Fundus photo, image size 1932x1910, FOV: 45 degrees: 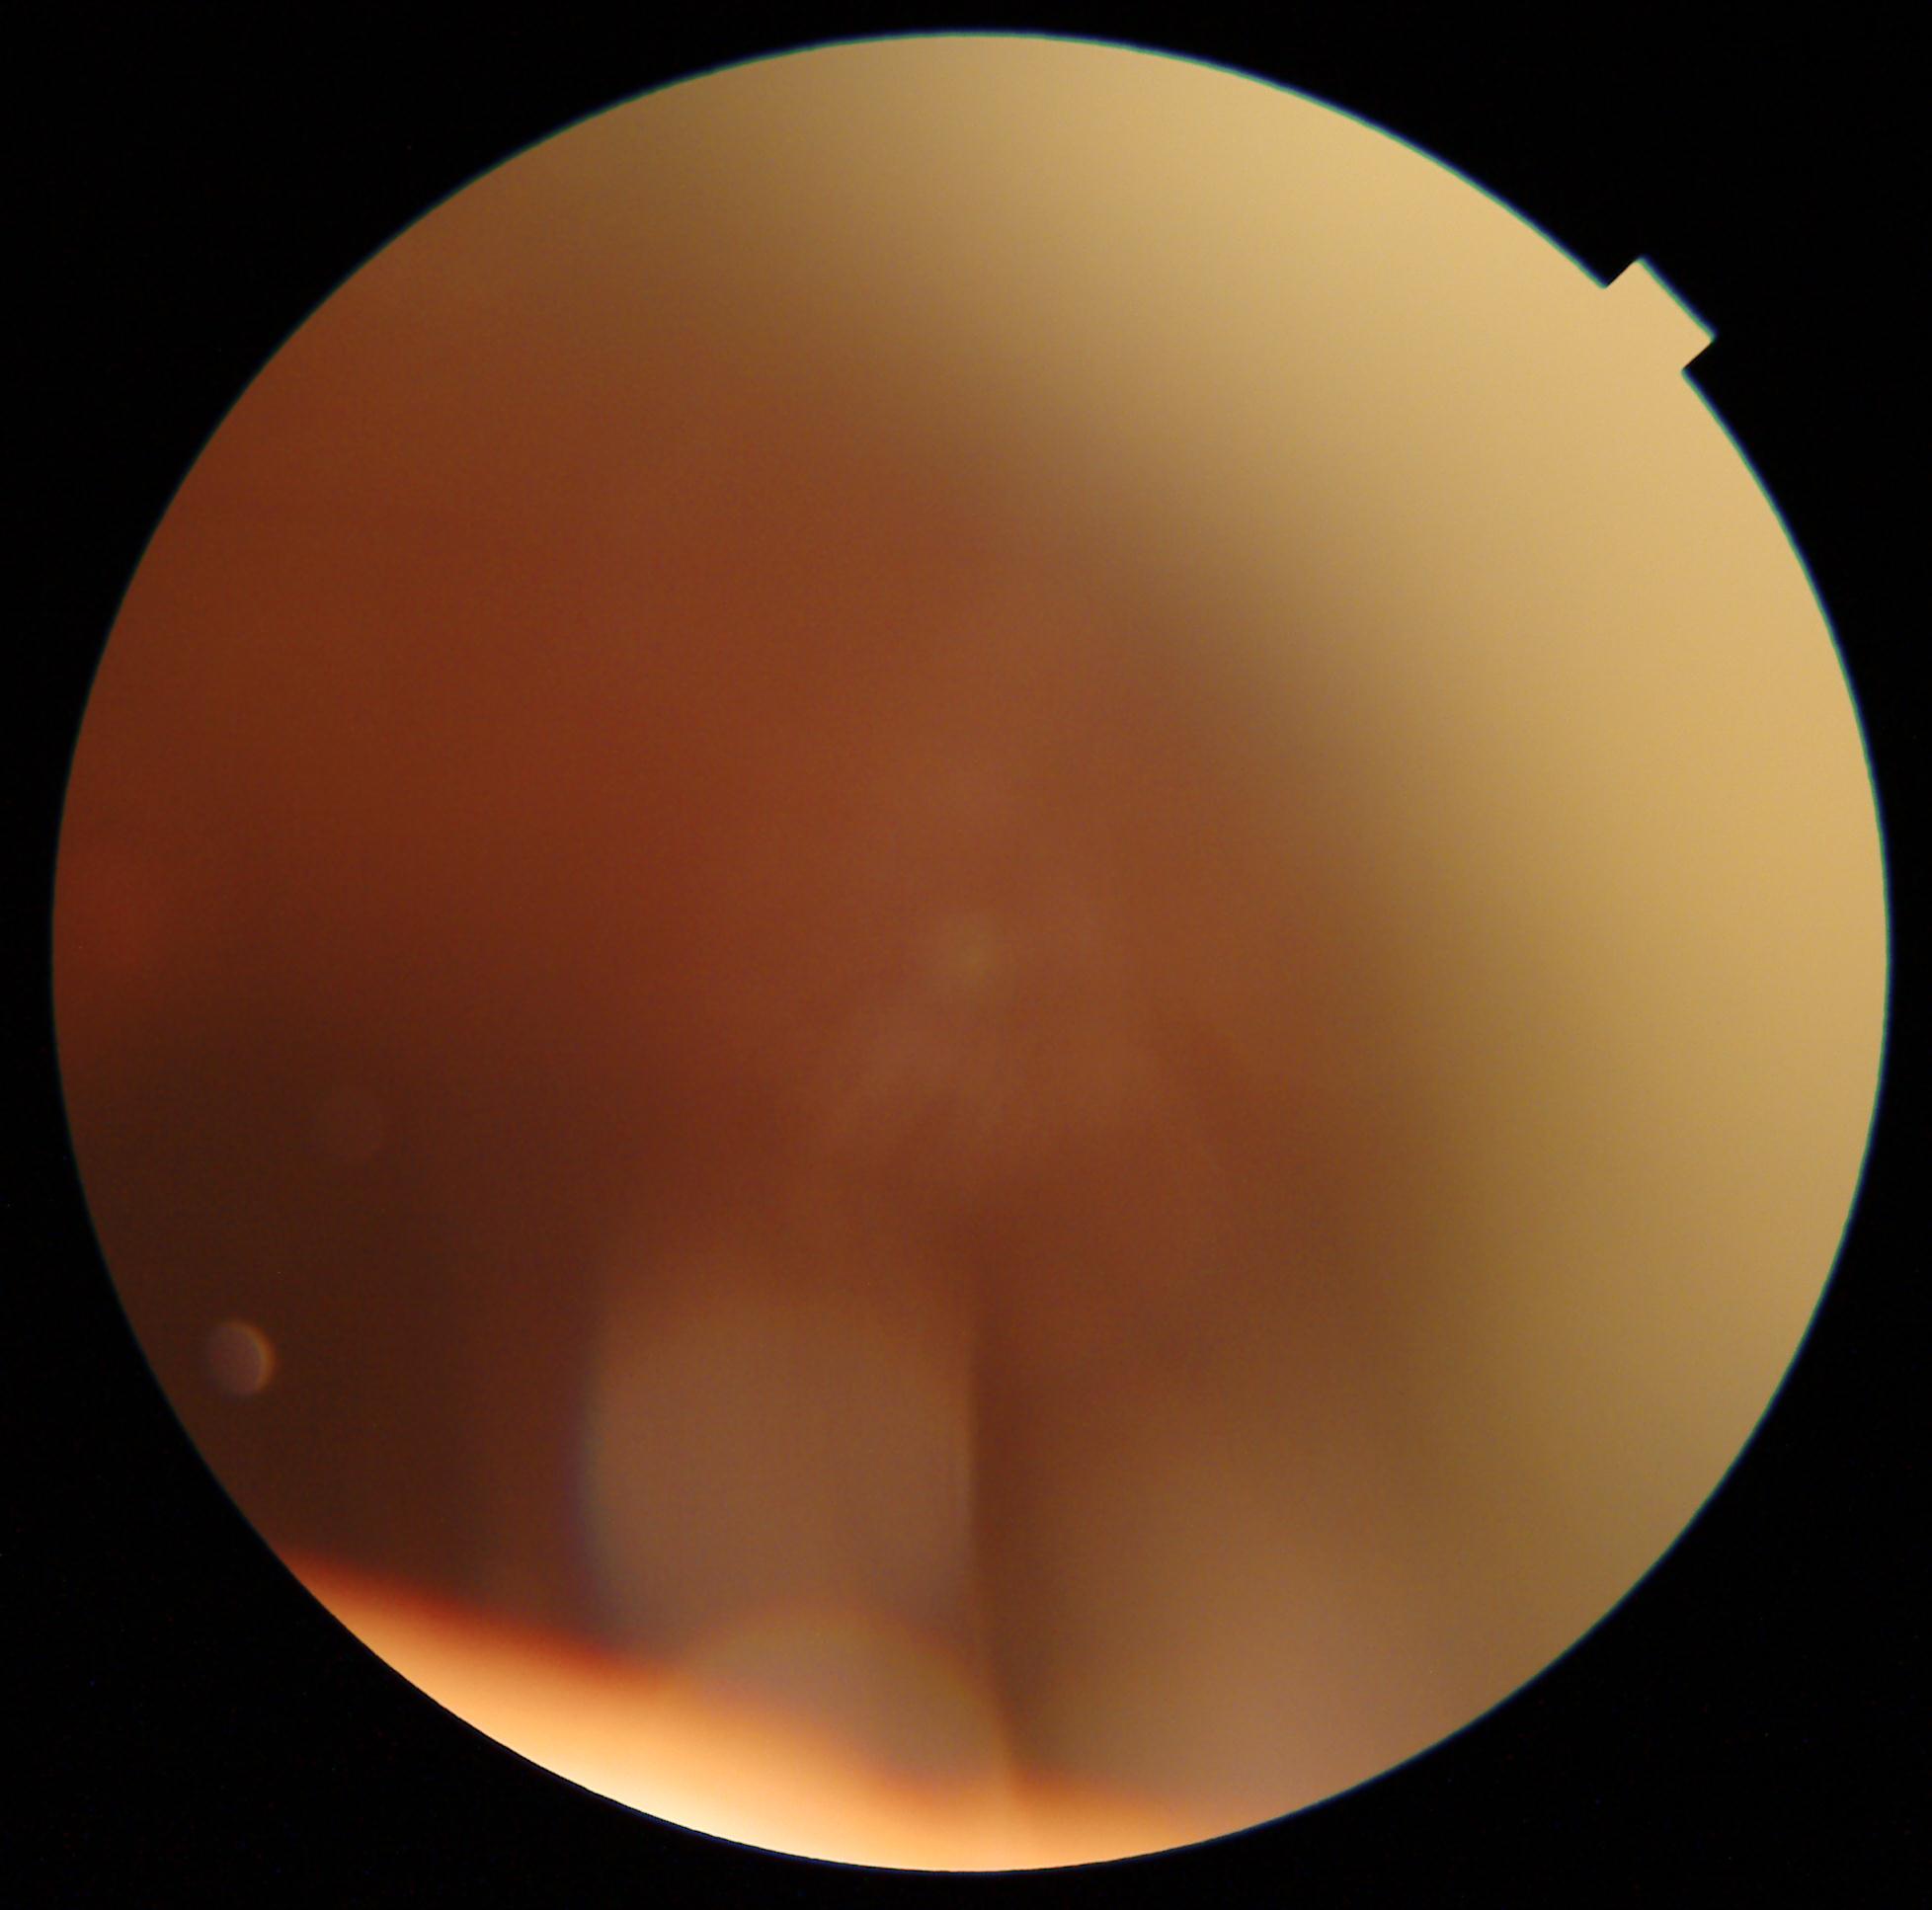
The image cannot be graded for diabetic retinopathy. DR grade: ungradable.